Color fundus image; image size 1932x1932 — 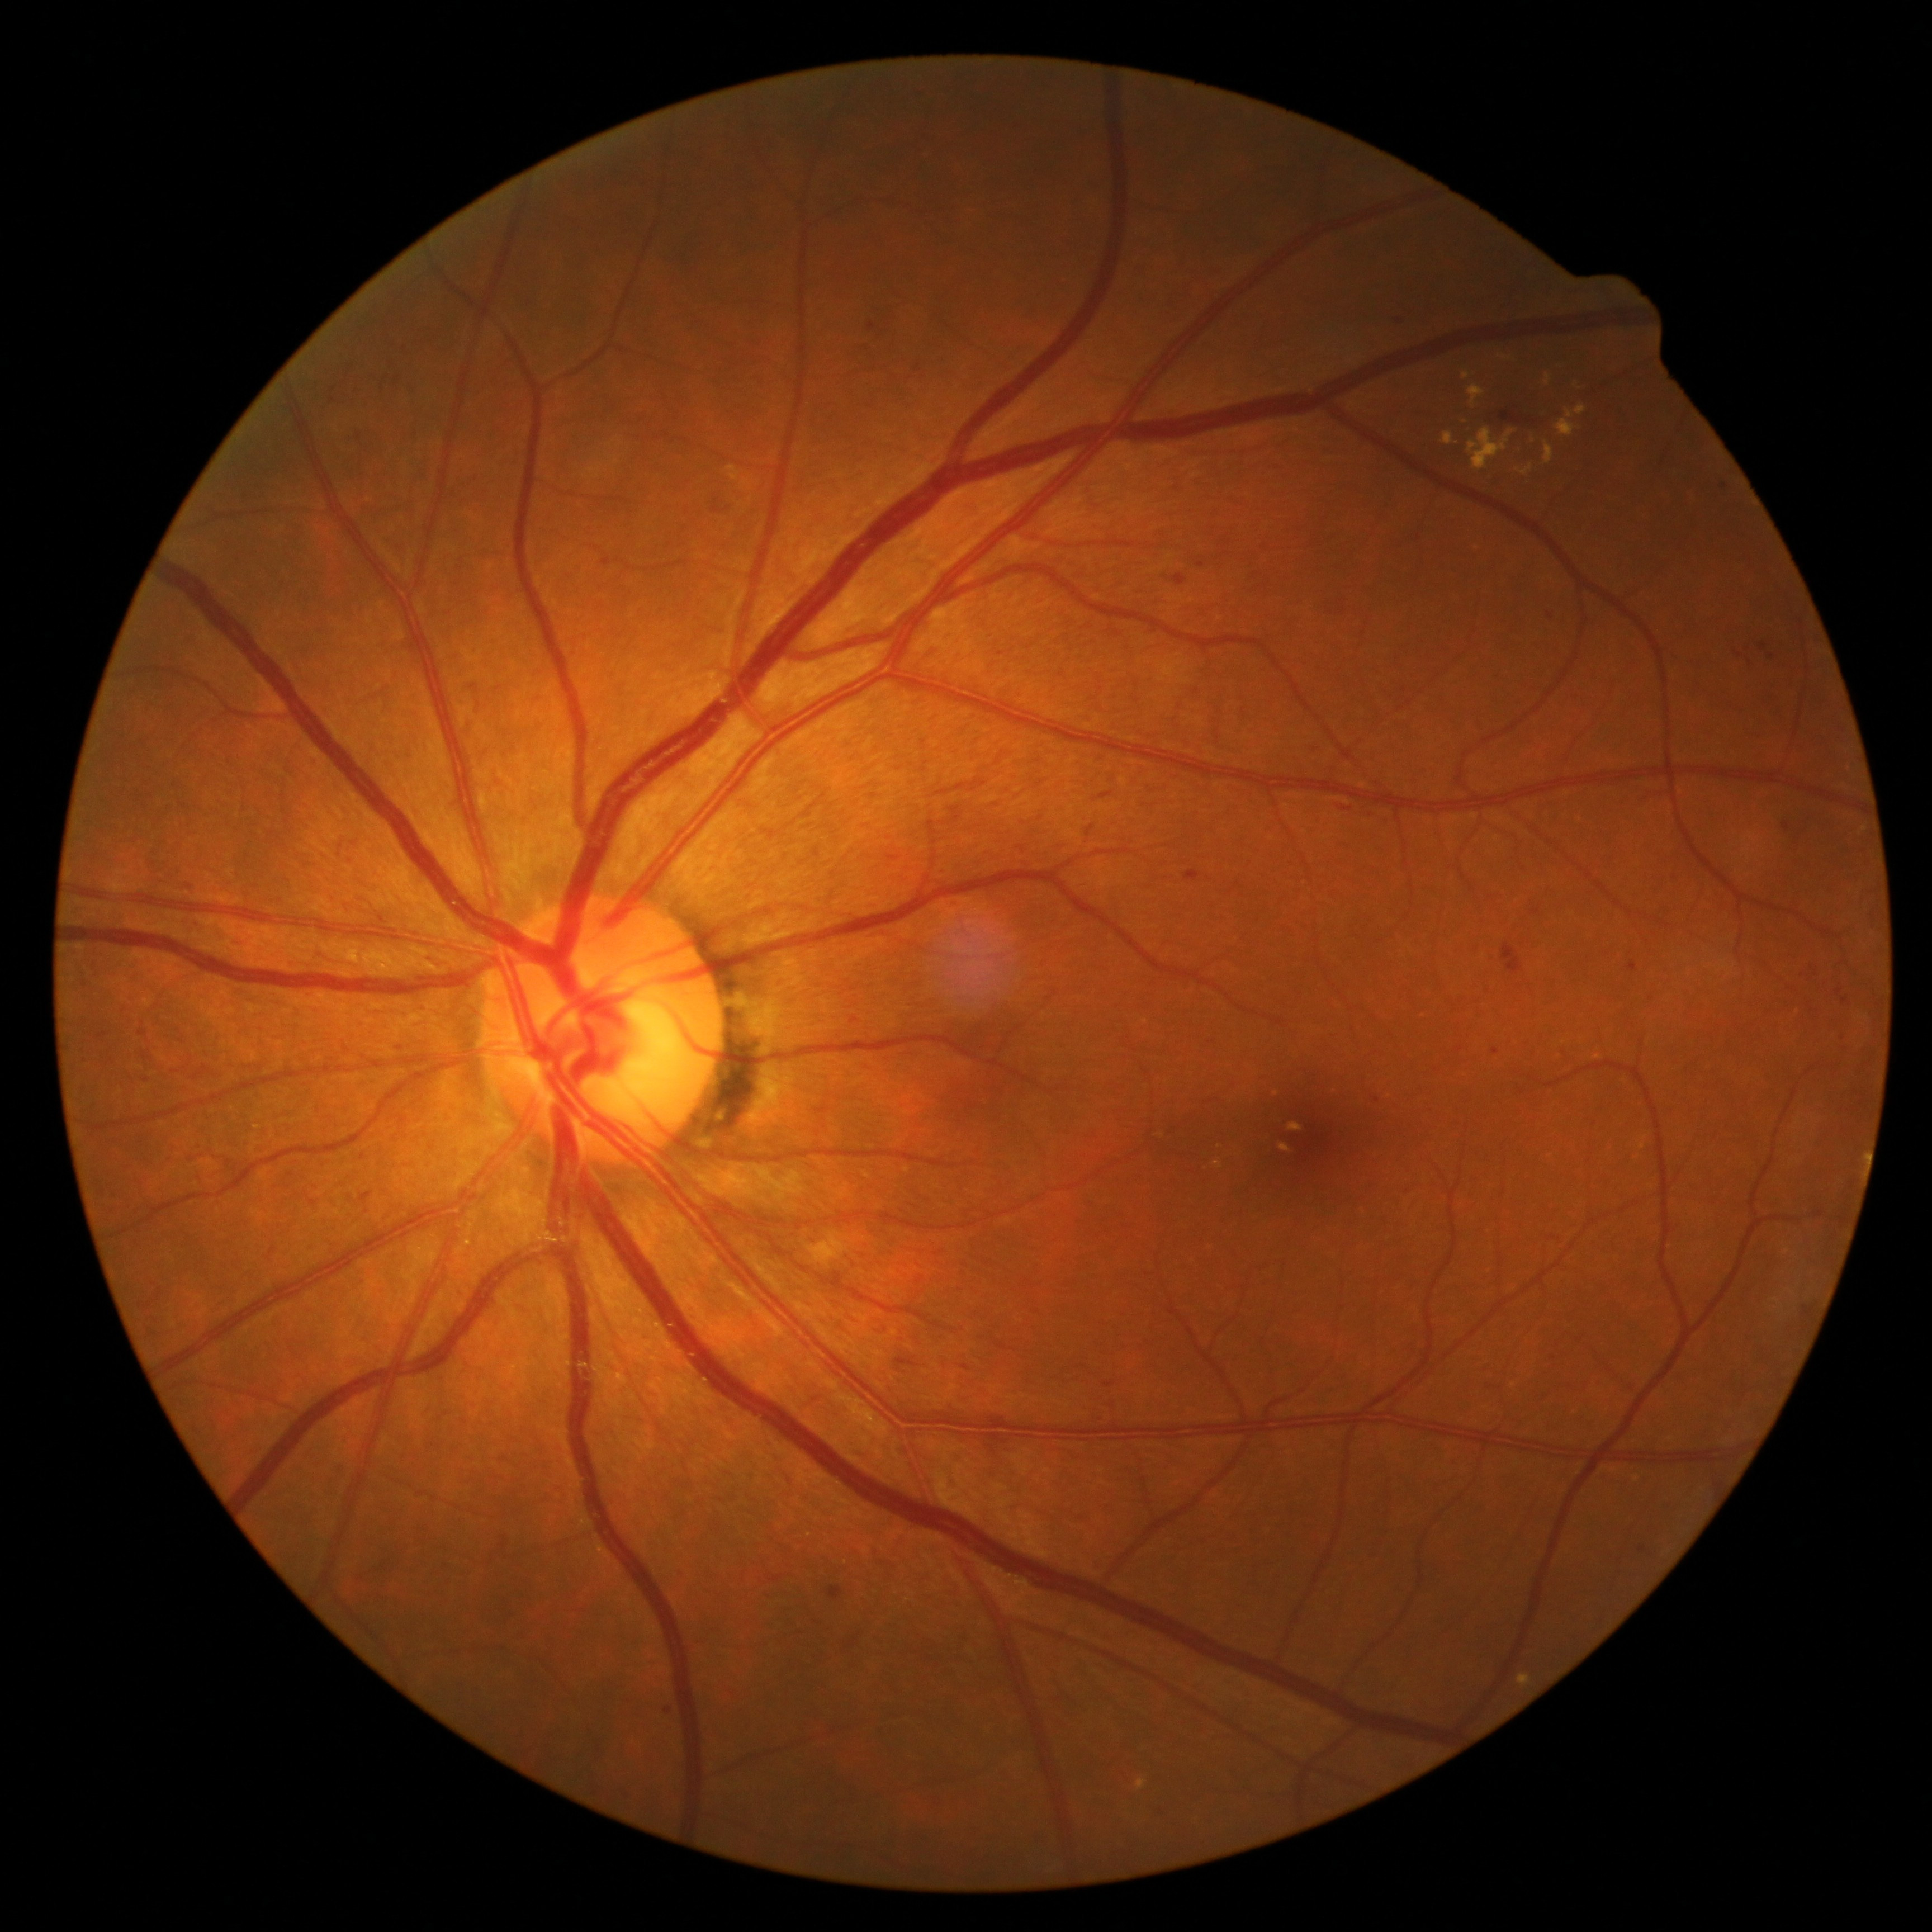 dr_grade: 2
dr_grade_name: moderate NPDR
lesions:
  ex:
    - l=1546, t=443, r=1555, b=465
    - l=1469, t=386, r=1484, b=408
    - l=1469, t=428, r=1516, b=470
    - l=1443, t=431, r=1454, b=446
    - l=1517, t=465, r=1533, b=476
    - l=1463, t=373, r=1470, b=381
    - l=1289, t=1123, r=1303, b=1132
    - l=1519, t=1674, r=1531, b=1685
    - l=1280, t=1144, r=1291, b=1151
    - l=1557, t=420, r=1578, b=437
    - l=1138, t=1778, r=1147, b=1791
    - l=1546, t=373, r=1551, b=384
    - l=1566, t=405, r=1587, b=419
  ex_small:
    - x=1533 y=441
  se: []
  ma:
    - l=1783, t=822, r=1791, b=831
    - l=1628, t=961, r=1637, b=972
    - l=828, t=1586, r=845, b=1598
    - l=361, t=1192, r=372, b=1204
    - l=914, t=366, r=922, b=374
    - l=1492, t=1047, r=1499, b=1055
    - l=1103, t=1381, r=1116, b=1387
    - l=868, t=323, r=877, b=333
    - l=1197, t=562, r=1206, b=567
    - l=1173, t=574, r=1188, b=585
    - l=1842, t=997, r=1850, b=1005
    - l=1759, t=642, r=1767, b=652
    - l=1391, t=309, r=1401, b=321
  ma_small:
    - x=1724 y=487
    - x=668 y=1710
    - x=1550 y=615
    - x=1643 y=1548
    - x=1377 y=1100
  he:
    - l=1501, t=943, r=1524, b=976
    - l=932, t=775, r=1006, b=803
    - l=1501, t=411, r=1524, b=425
    - l=1100, t=792, r=1112, b=801
    - l=1185, t=872, r=1200, b=882
    - l=895, t=1356, r=920, b=1367